Pediatric wide-field fundus photograph: 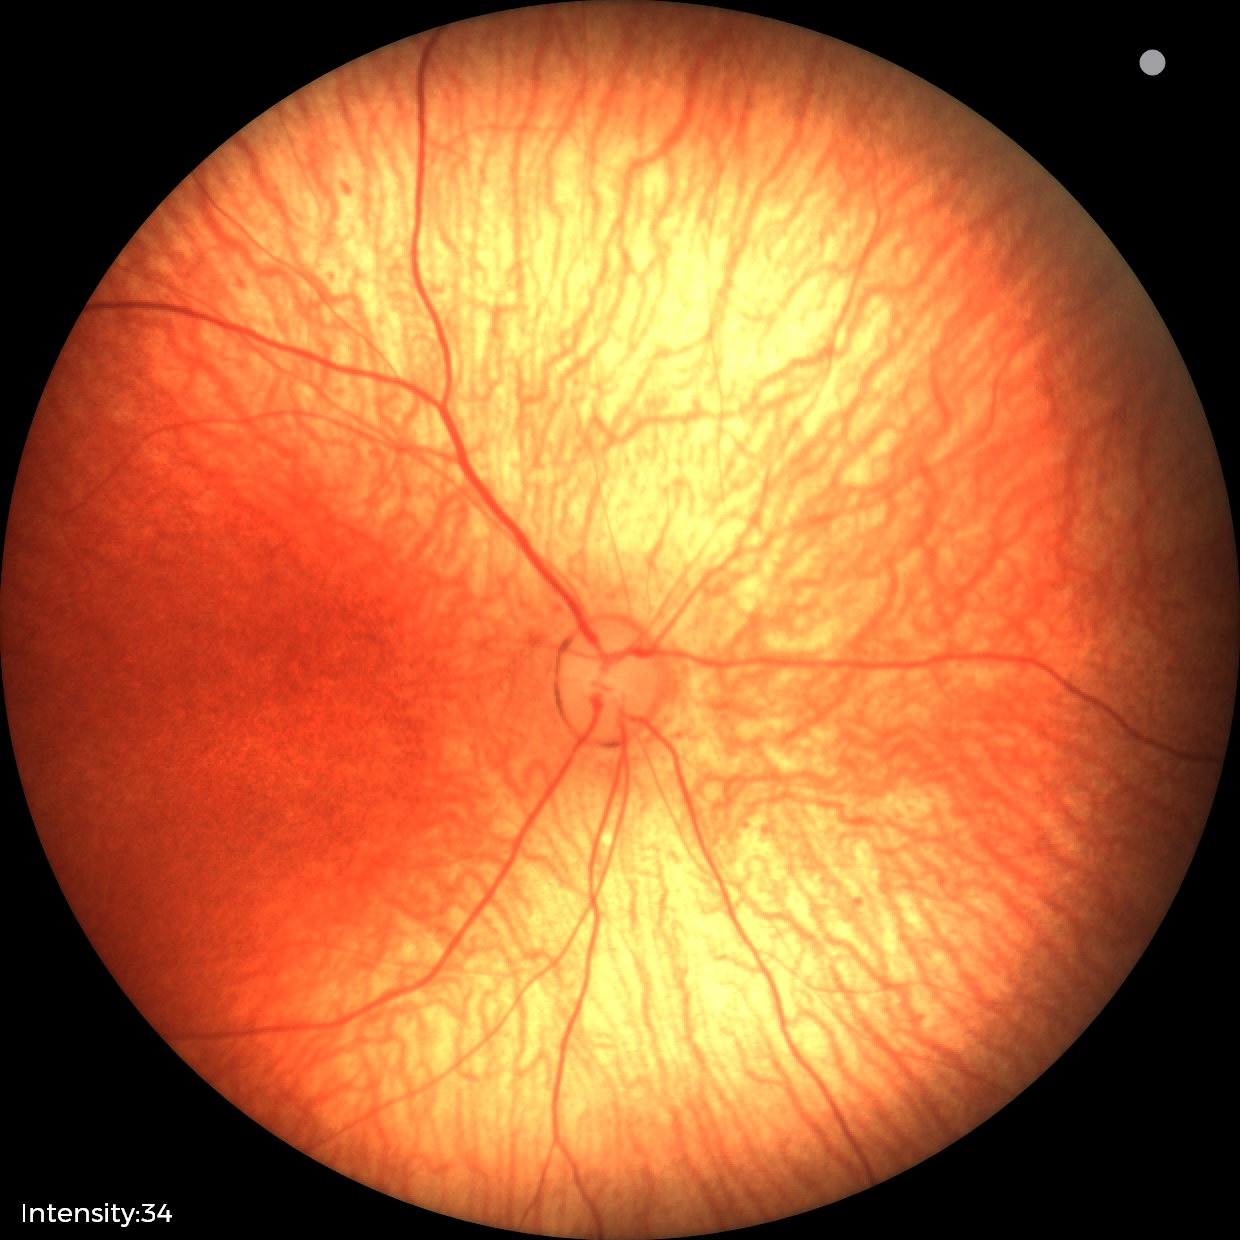
Diagnosis: normal.